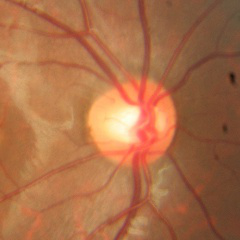 Optic nerve head appearance consistent with no glaucomatous findings.